Fundus photo.
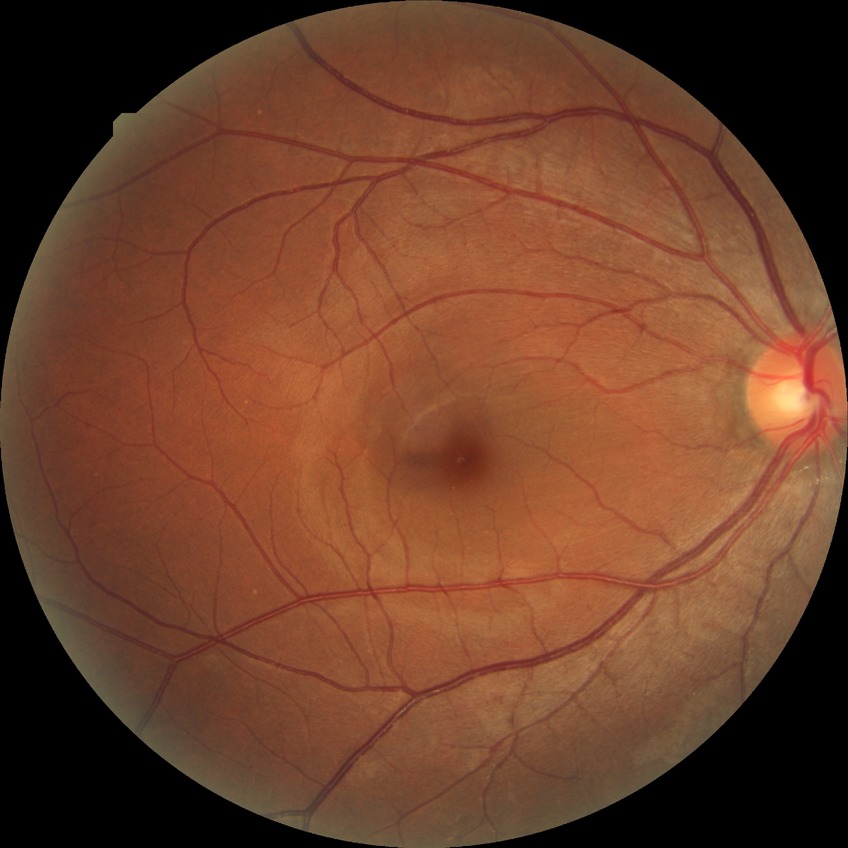

modified Davis classification = no diabetic retinopathy.